Portable fundus camera image · 60-degree field of view
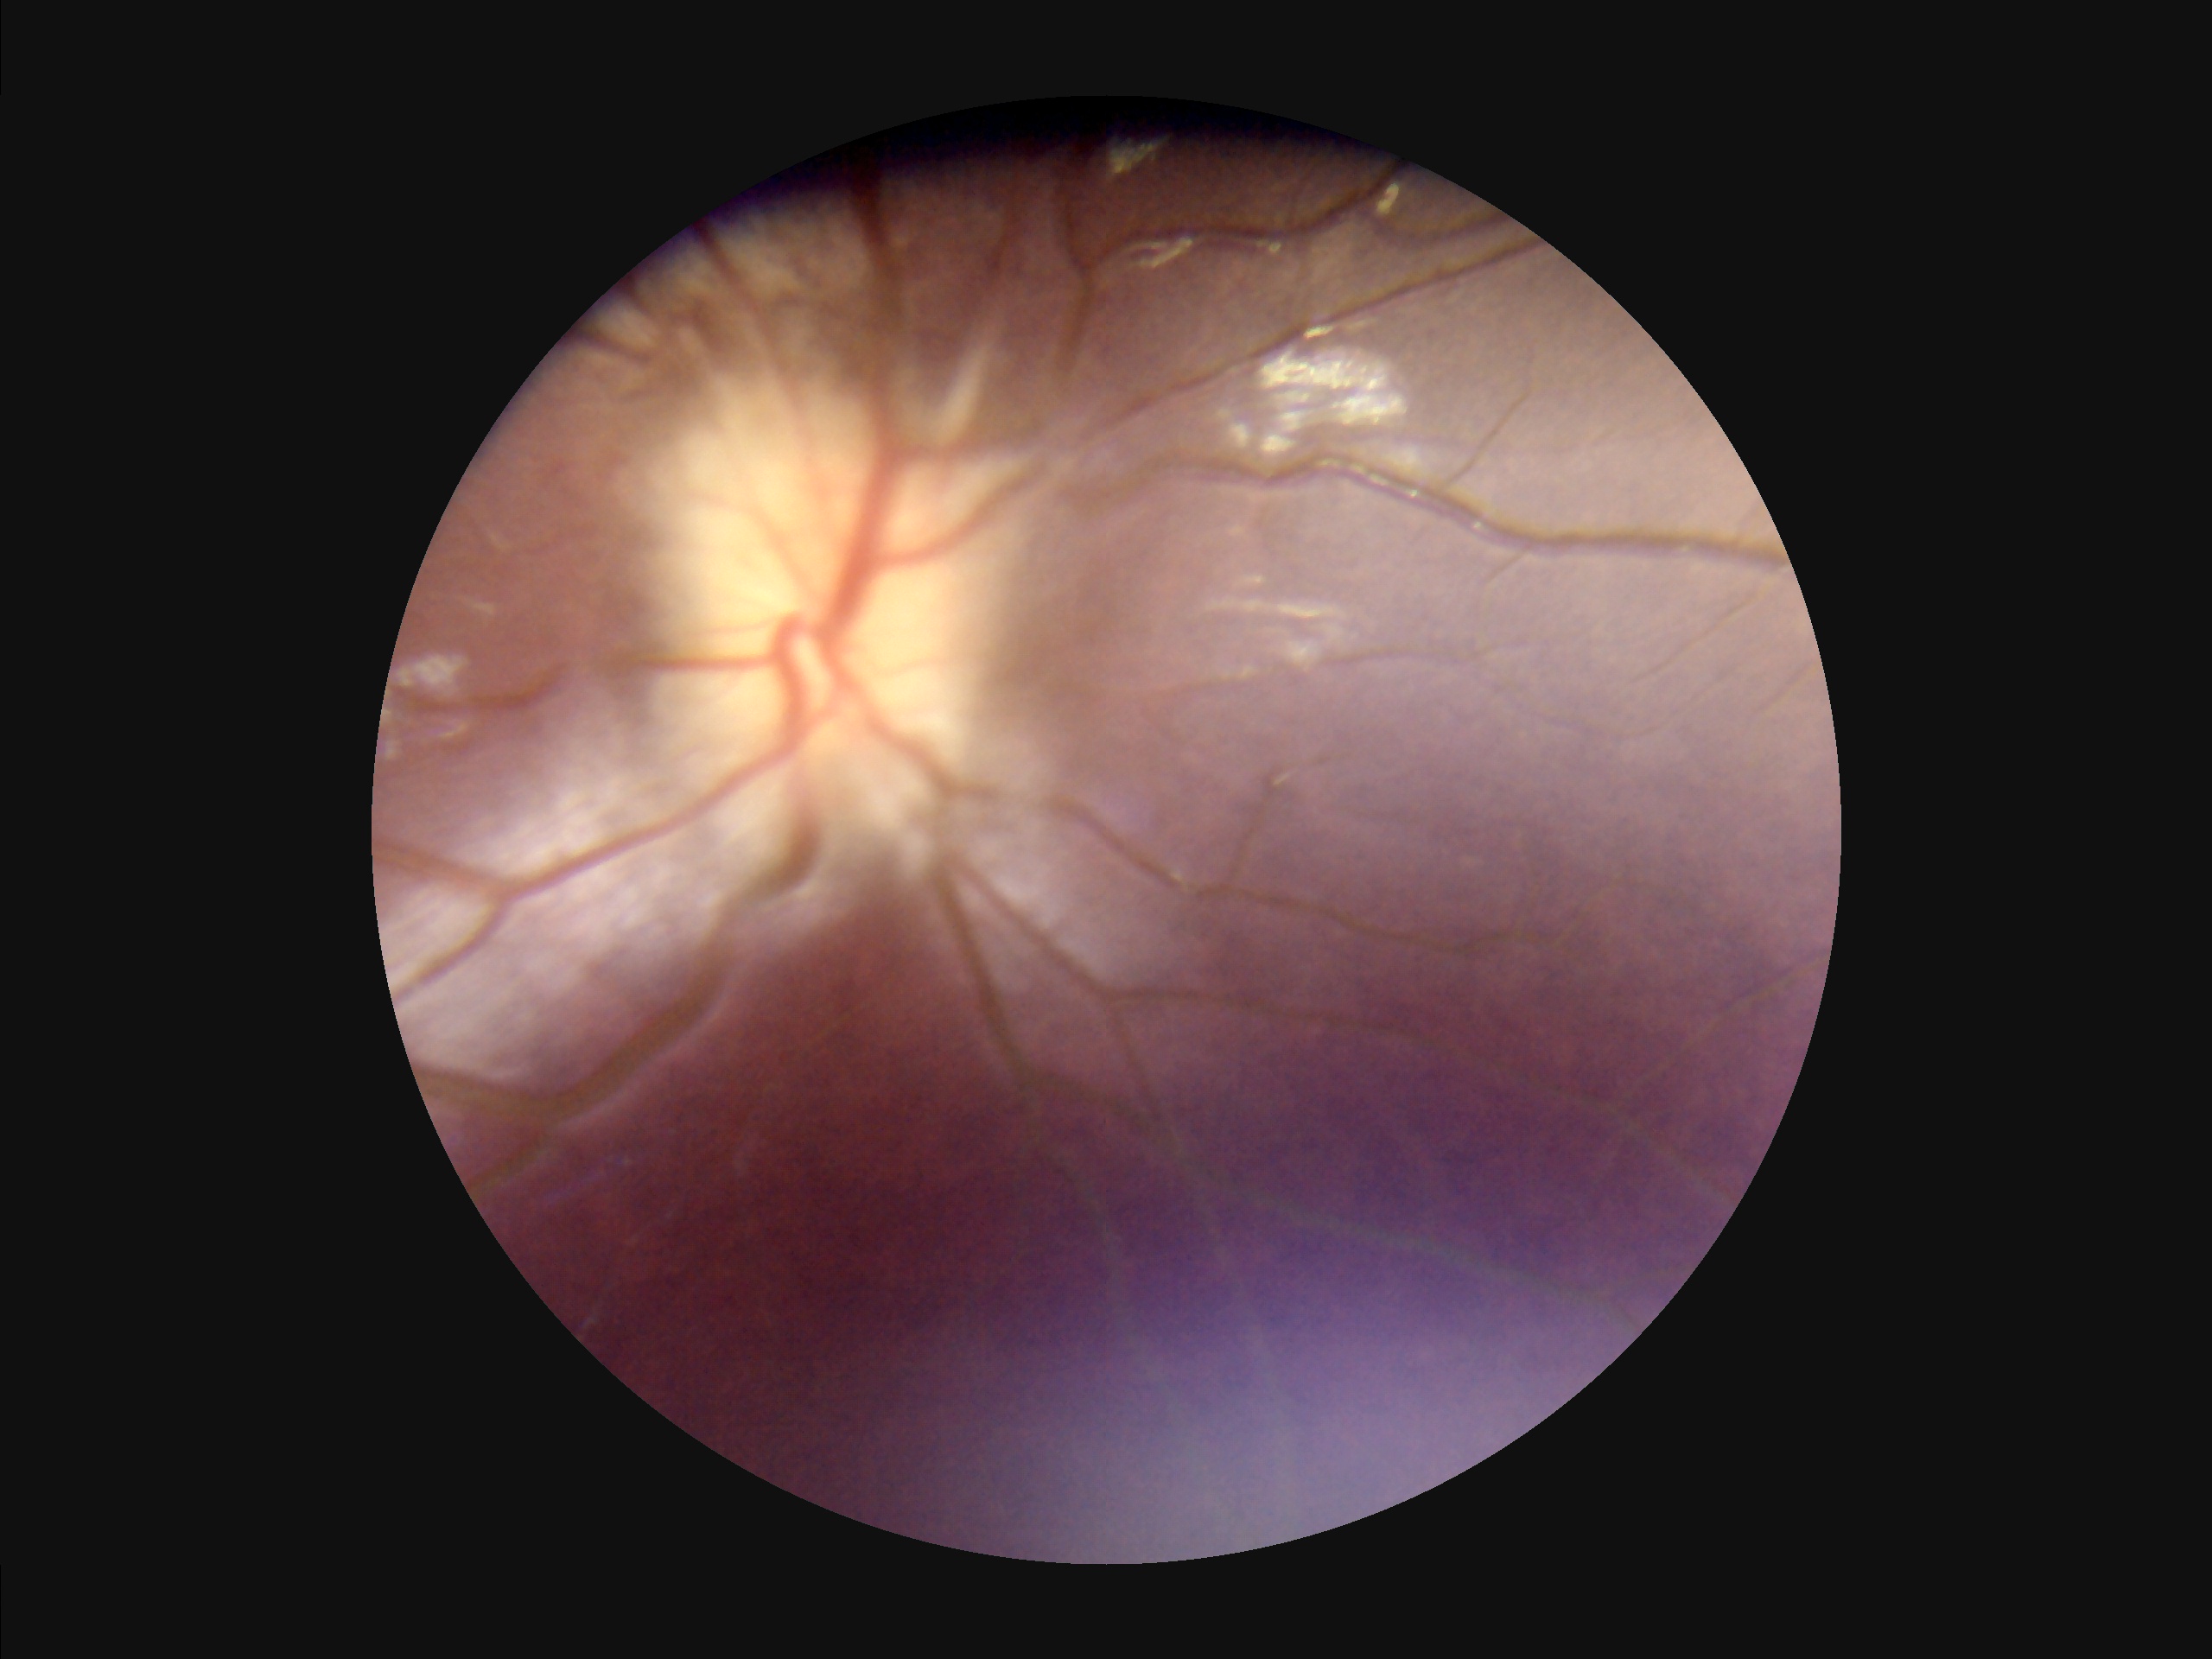
Noticeable blur in the optic disc, vessels, or background.
Poor illumination with uneven exposure.
Image quality is suboptimal.
Contrast is low.